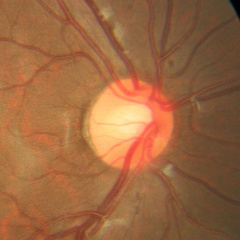

Glaucoma diagnosis: no glaucomatous findings.